640x480px. Pediatric wide-field fundus photograph — 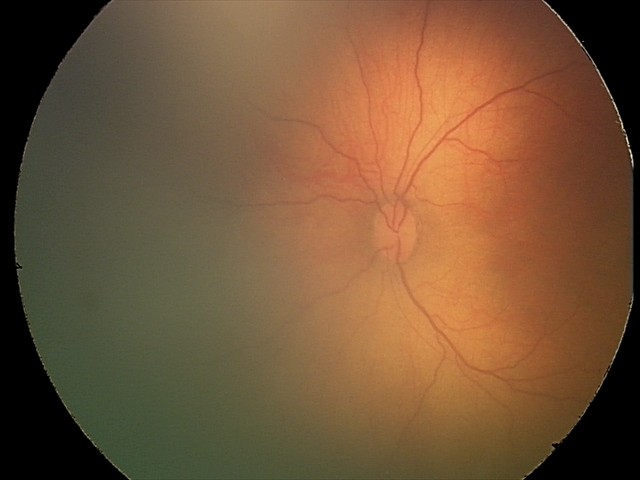

Screening examination with no abnormal retinal findings.